Color fundus photograph; 45-degree field of view — 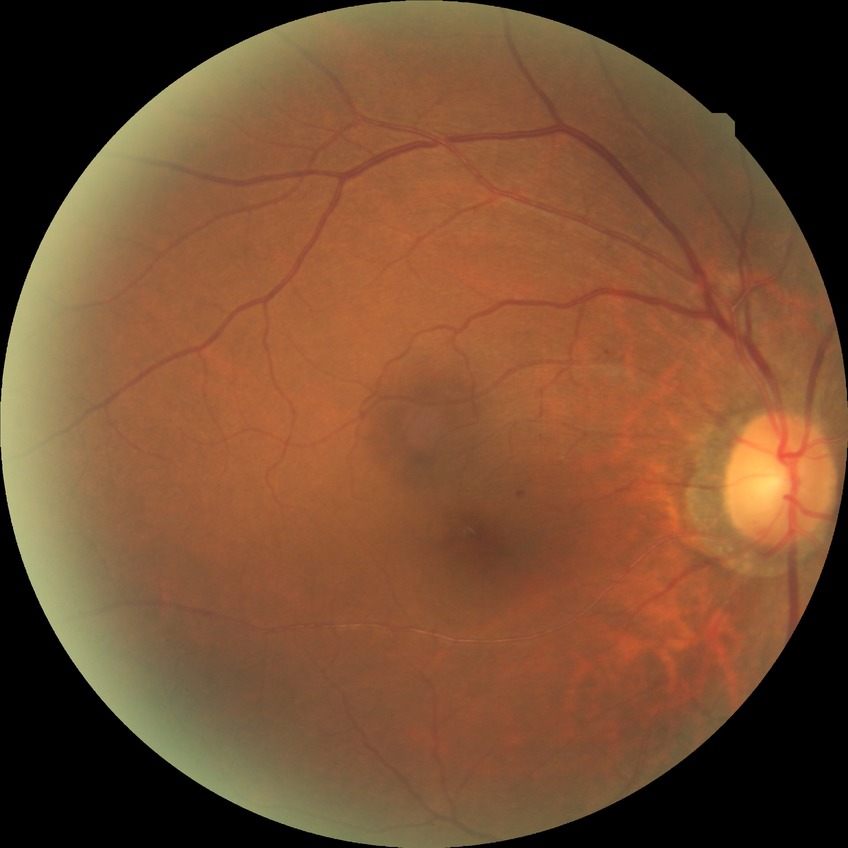

Retinopathy grade: simple diabetic retinopathy.